45° field of view — 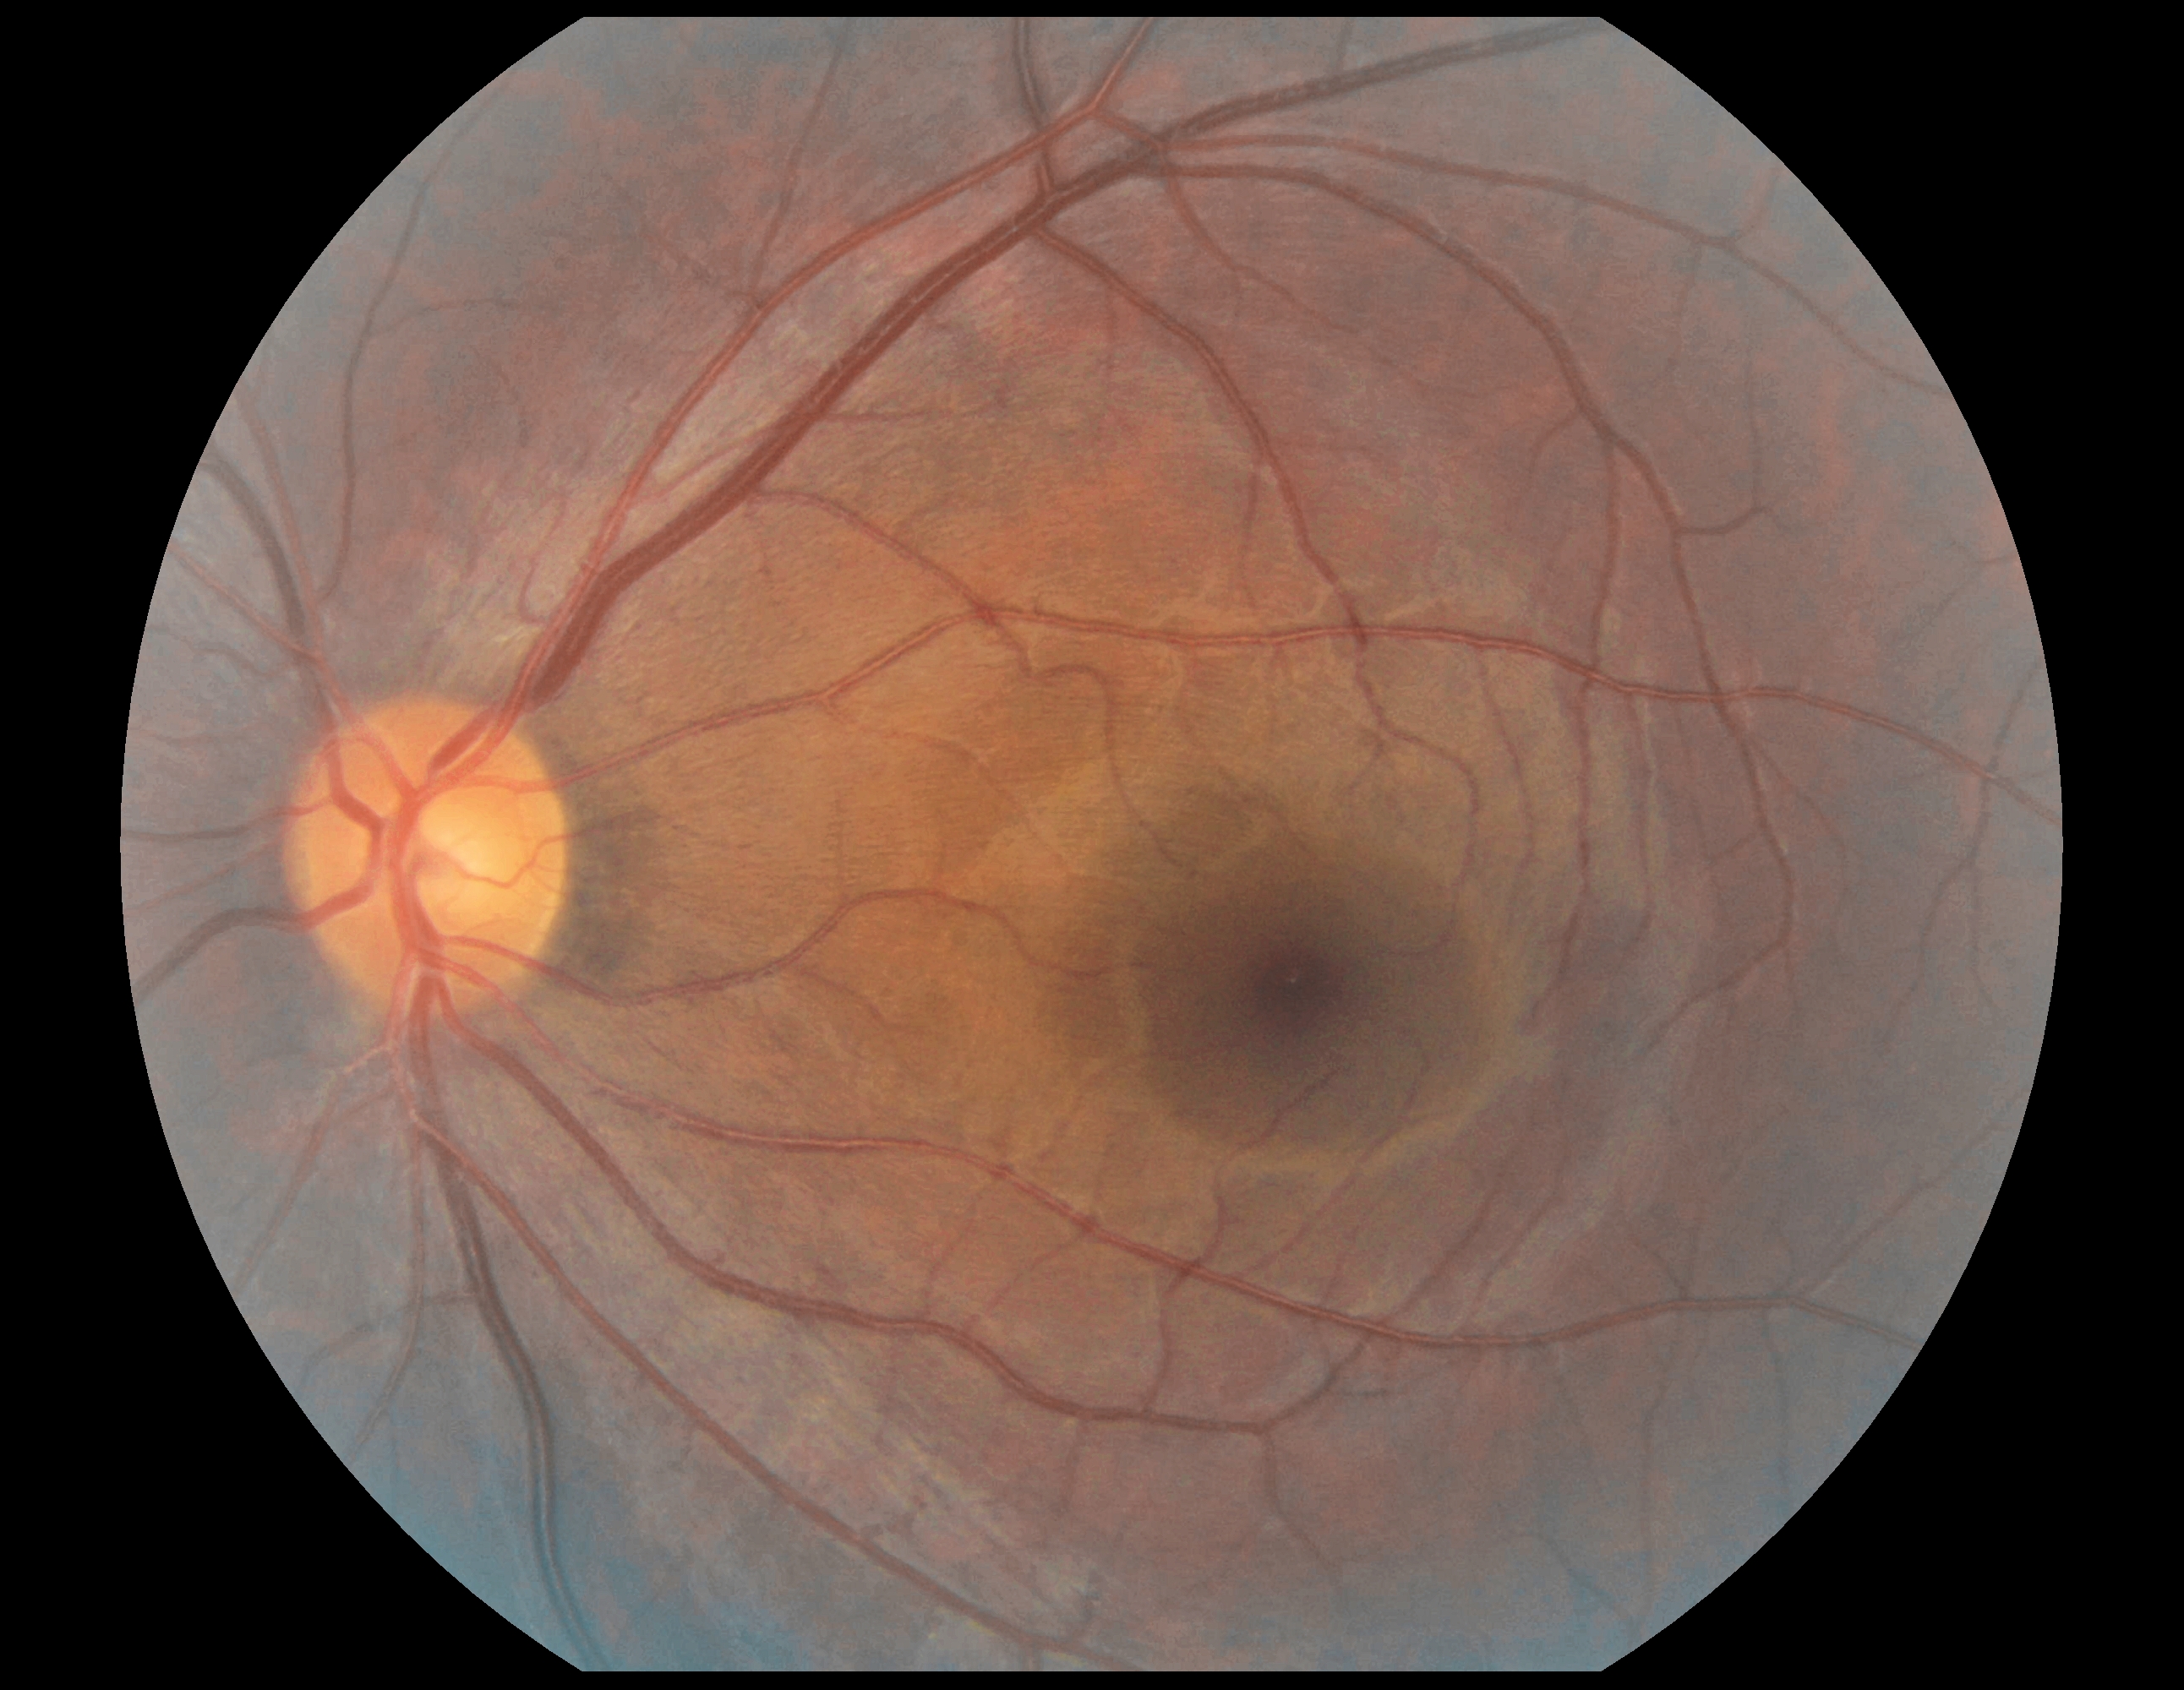

DR grade: no apparent diabetic retinopathy (0).